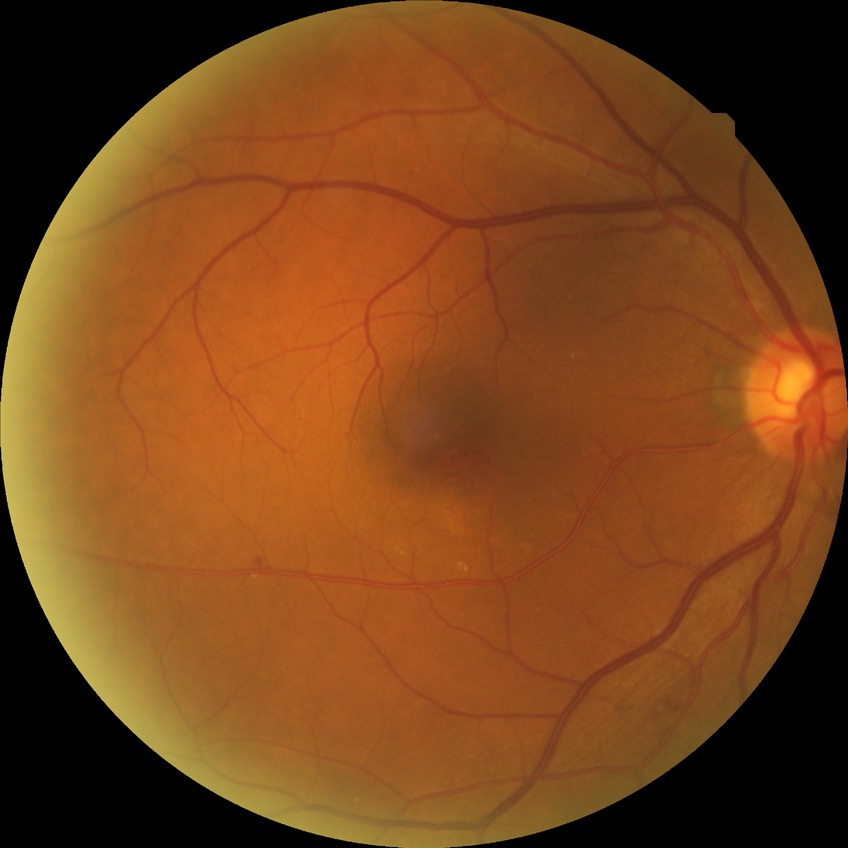
Findings:
* diabetic retinopathy (DR): simple diabetic retinopathy (SDR)